Color fundus image: 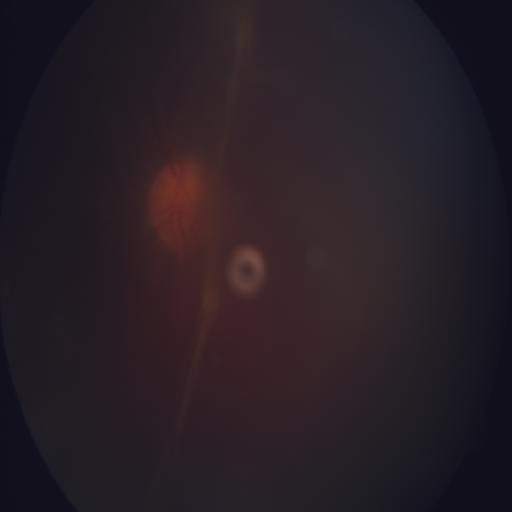

Diagnosis: retinal traction.